848x848px. Nonmydriatic. Acquired with a NIDEK AFC-230. Color fundus photograph. FOV: 45 degrees: 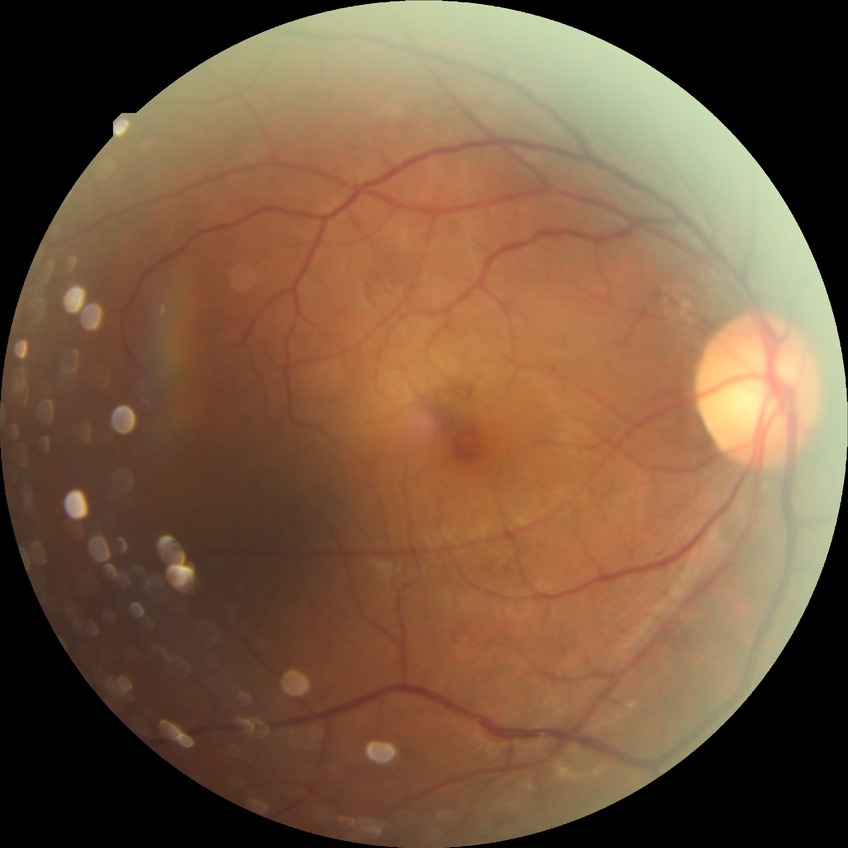

Retinopathy grade is simple diabetic retinopathy.